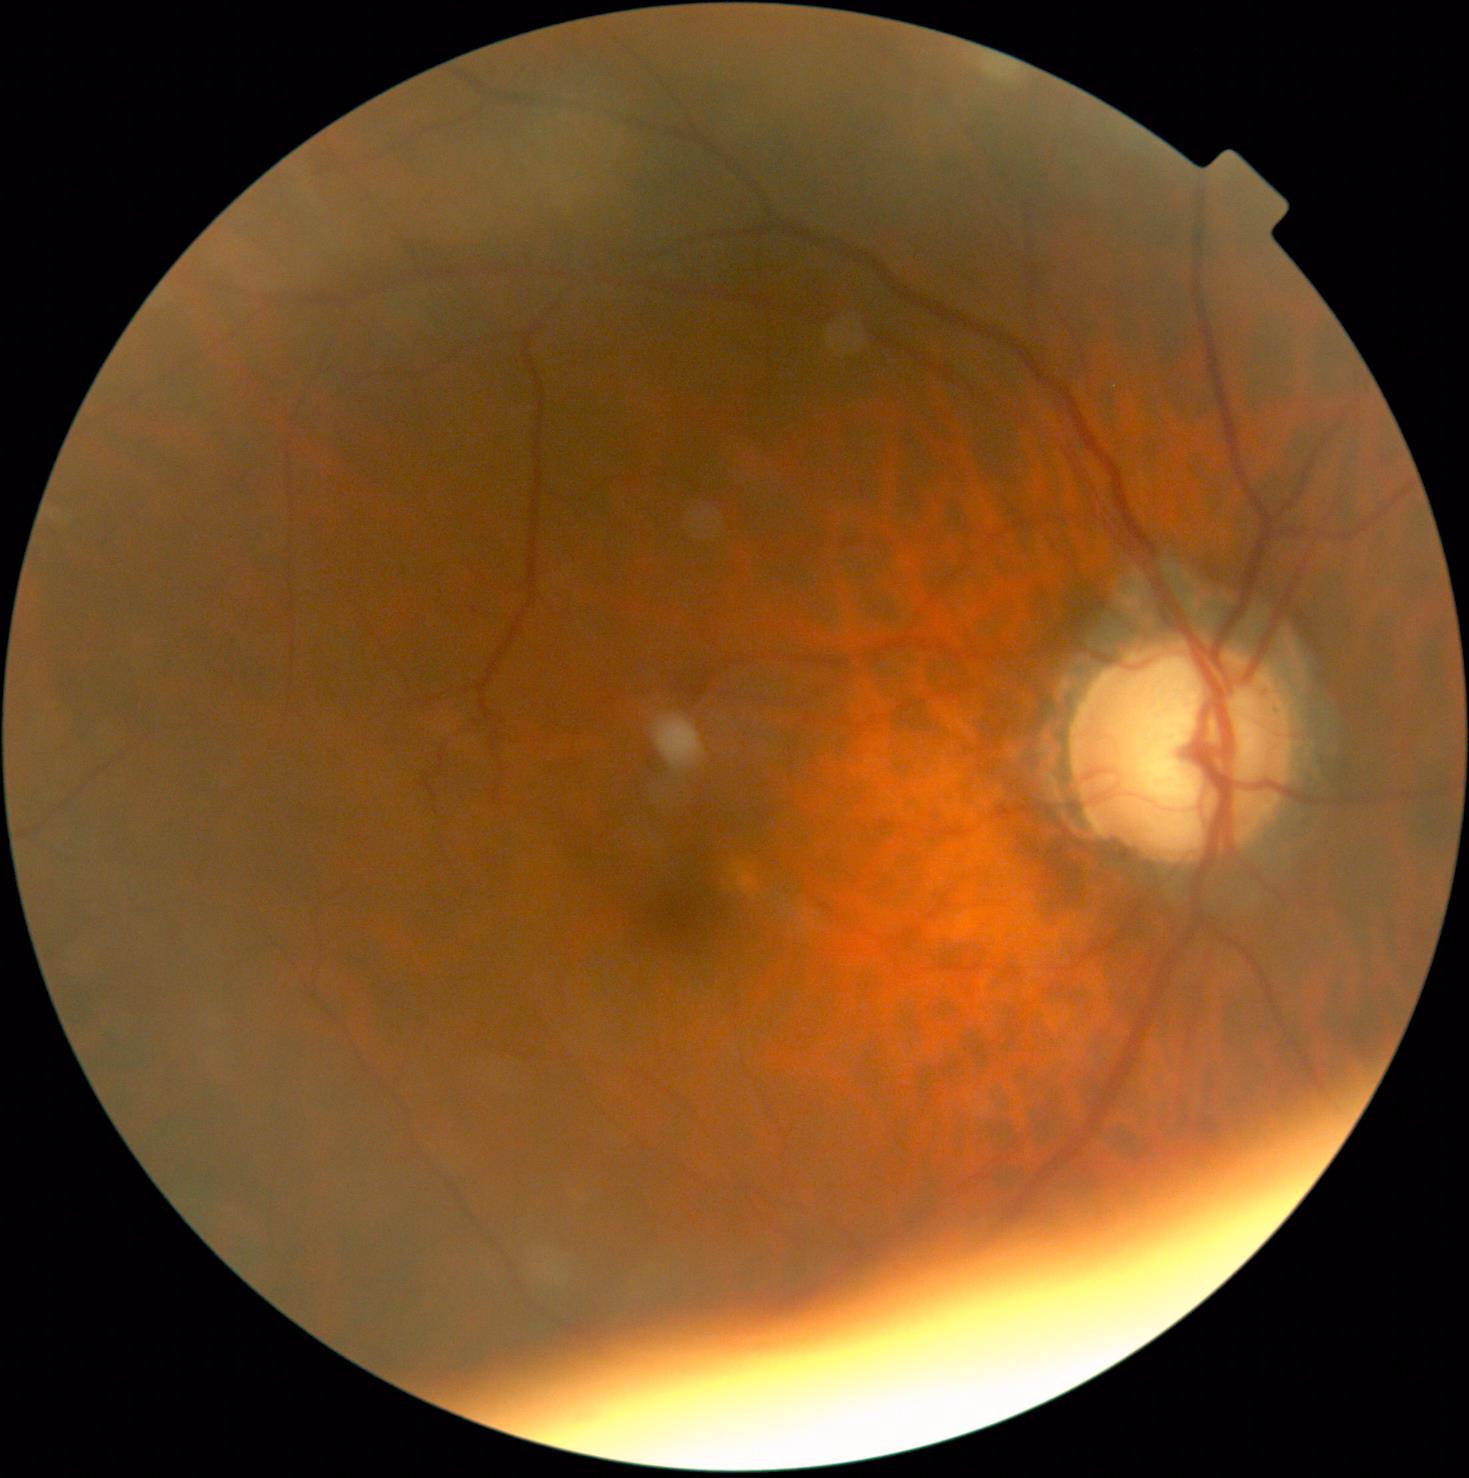

DR stage=grade 0 (no apparent retinopathy) — no visible signs of diabetic retinopathy.